Color fundus photograph — 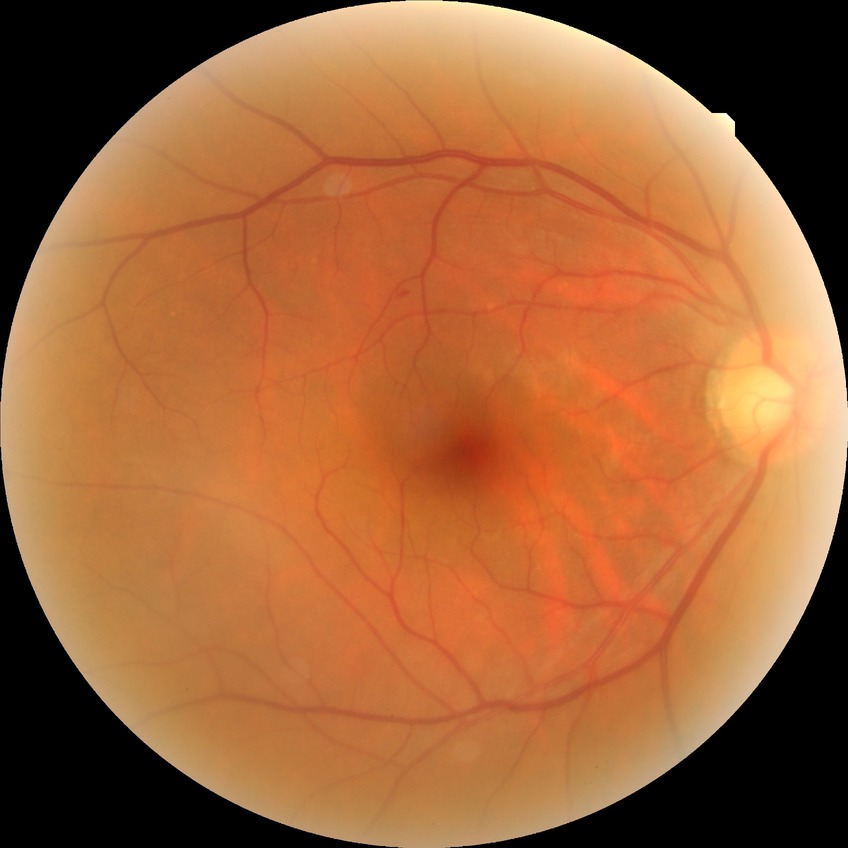

retinopathy stage: simple diabetic retinopathy